240 x 240 pixels
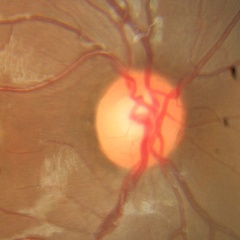 Optic nerve head appearance consistent with no evidence of glaucoma.